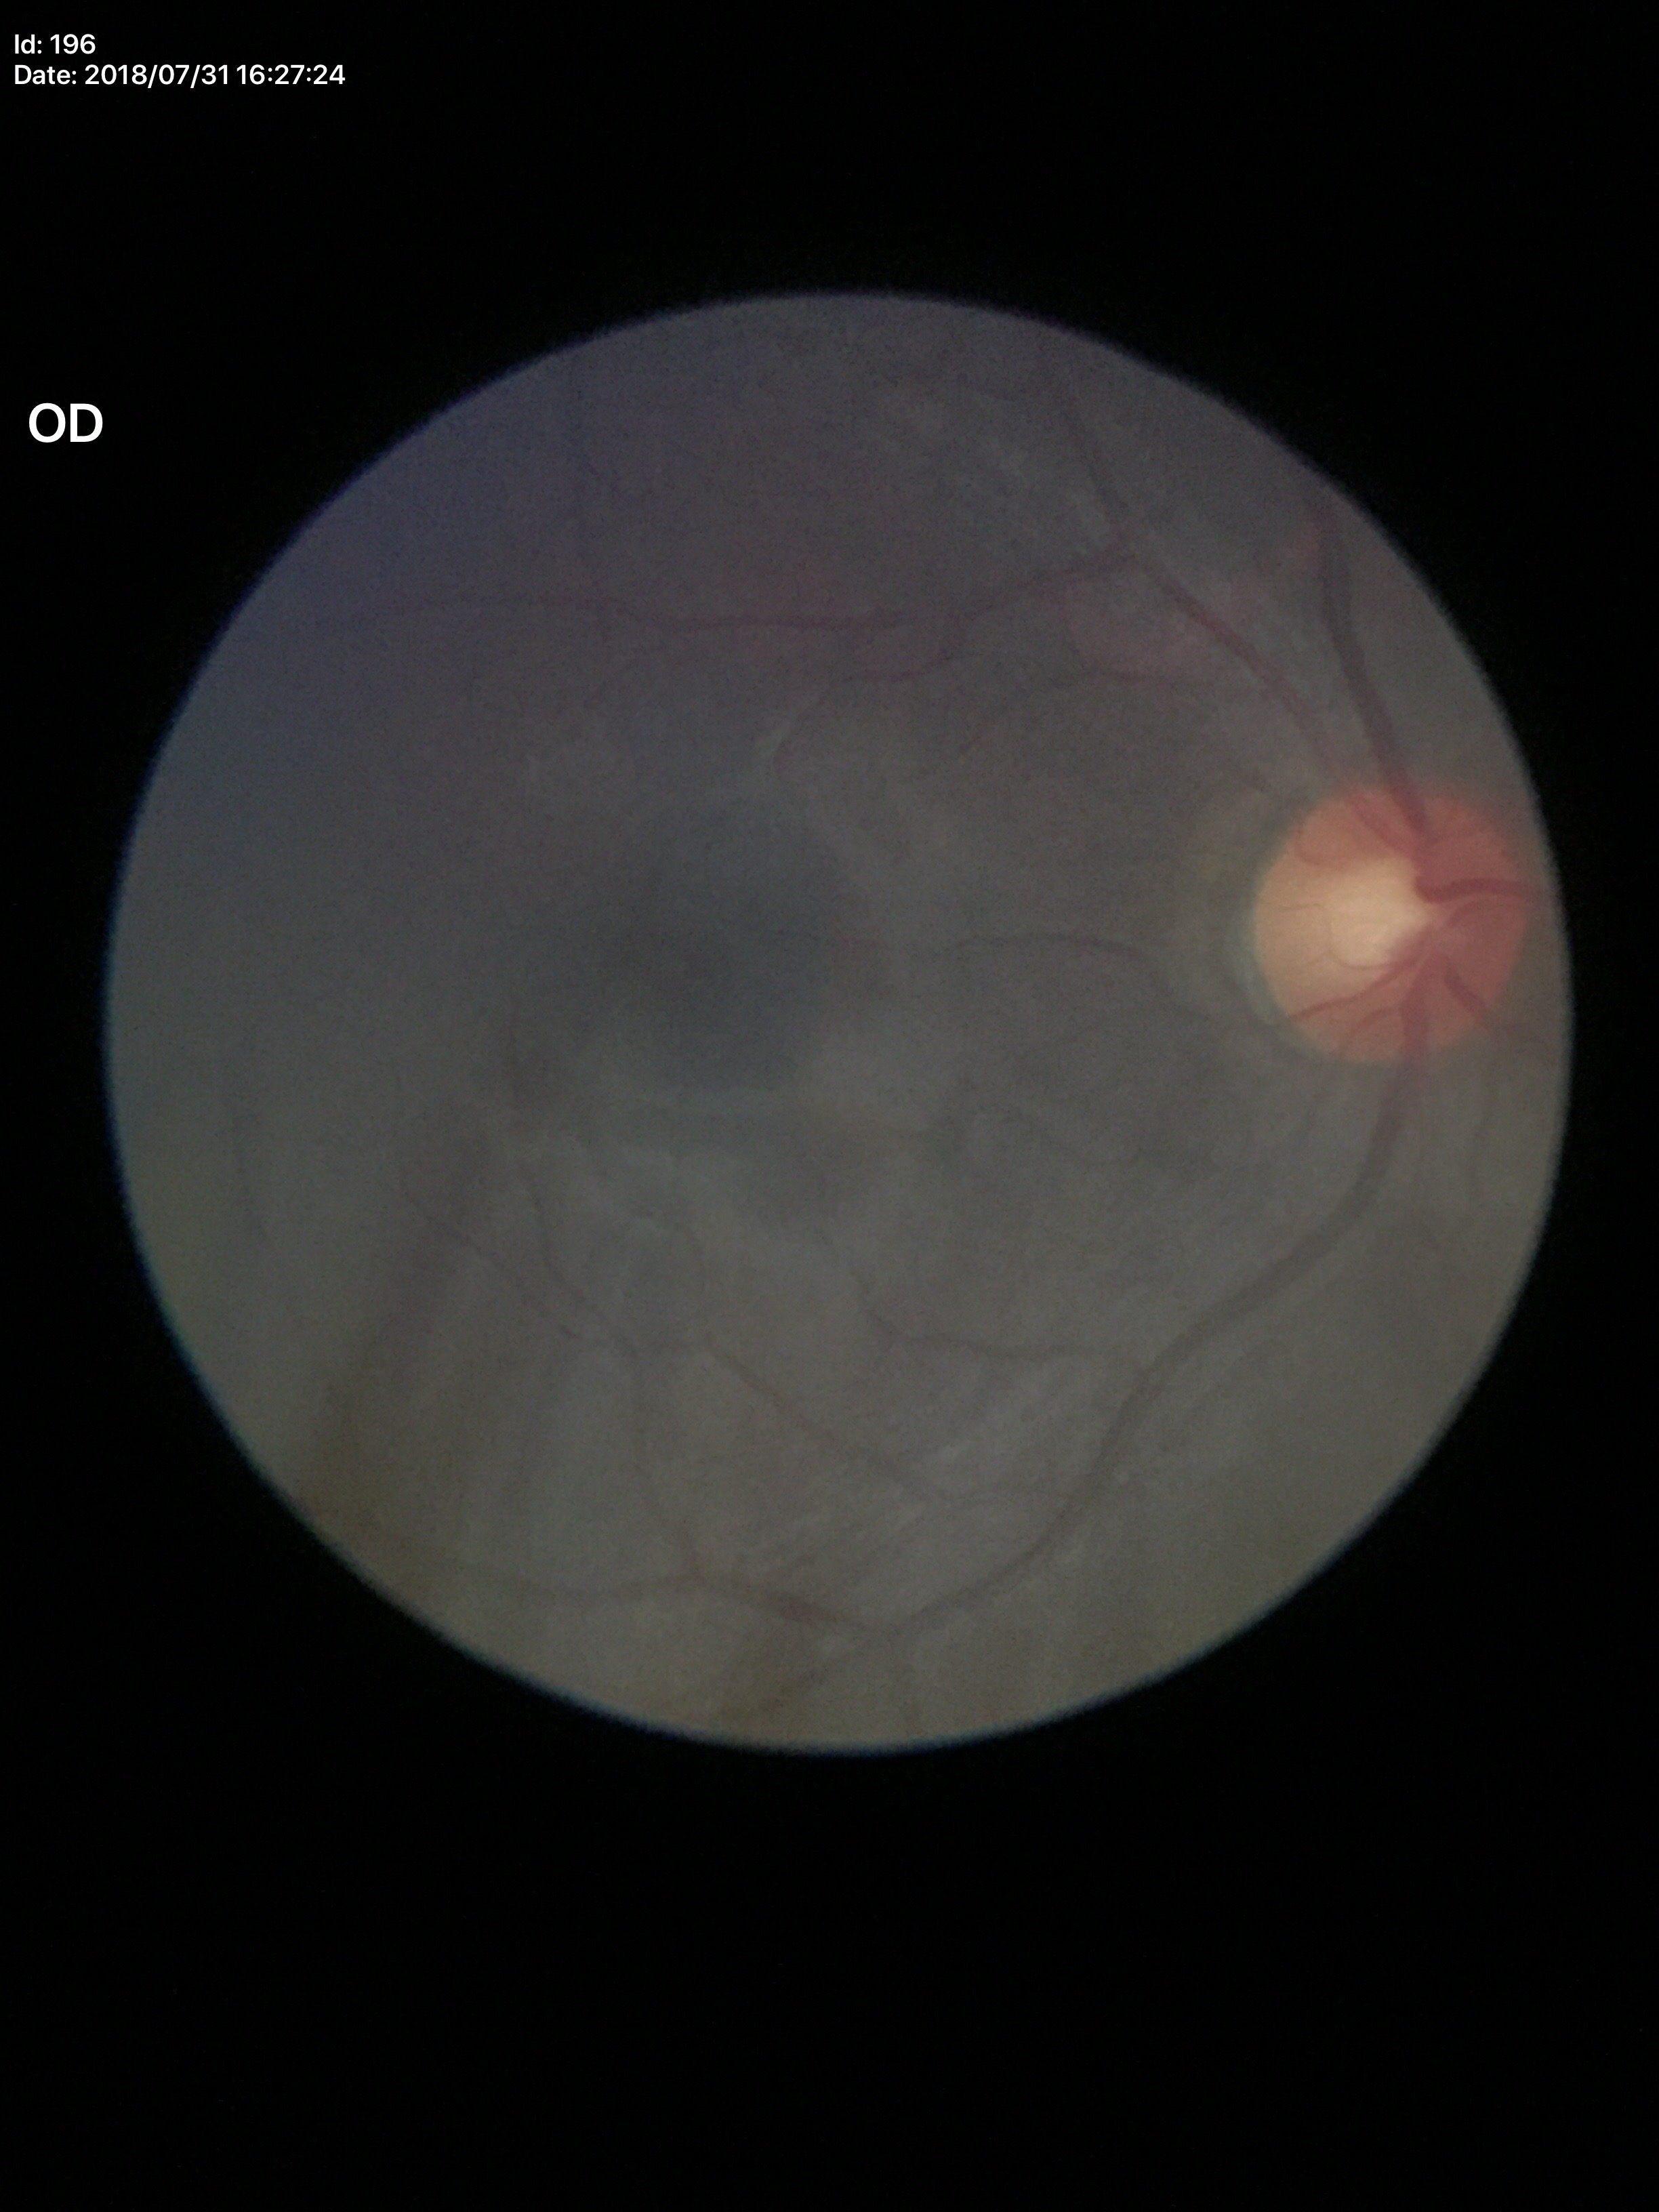

vertical cup-to-disc ratio: 0.54 | Glaucoma screening: not suspect.